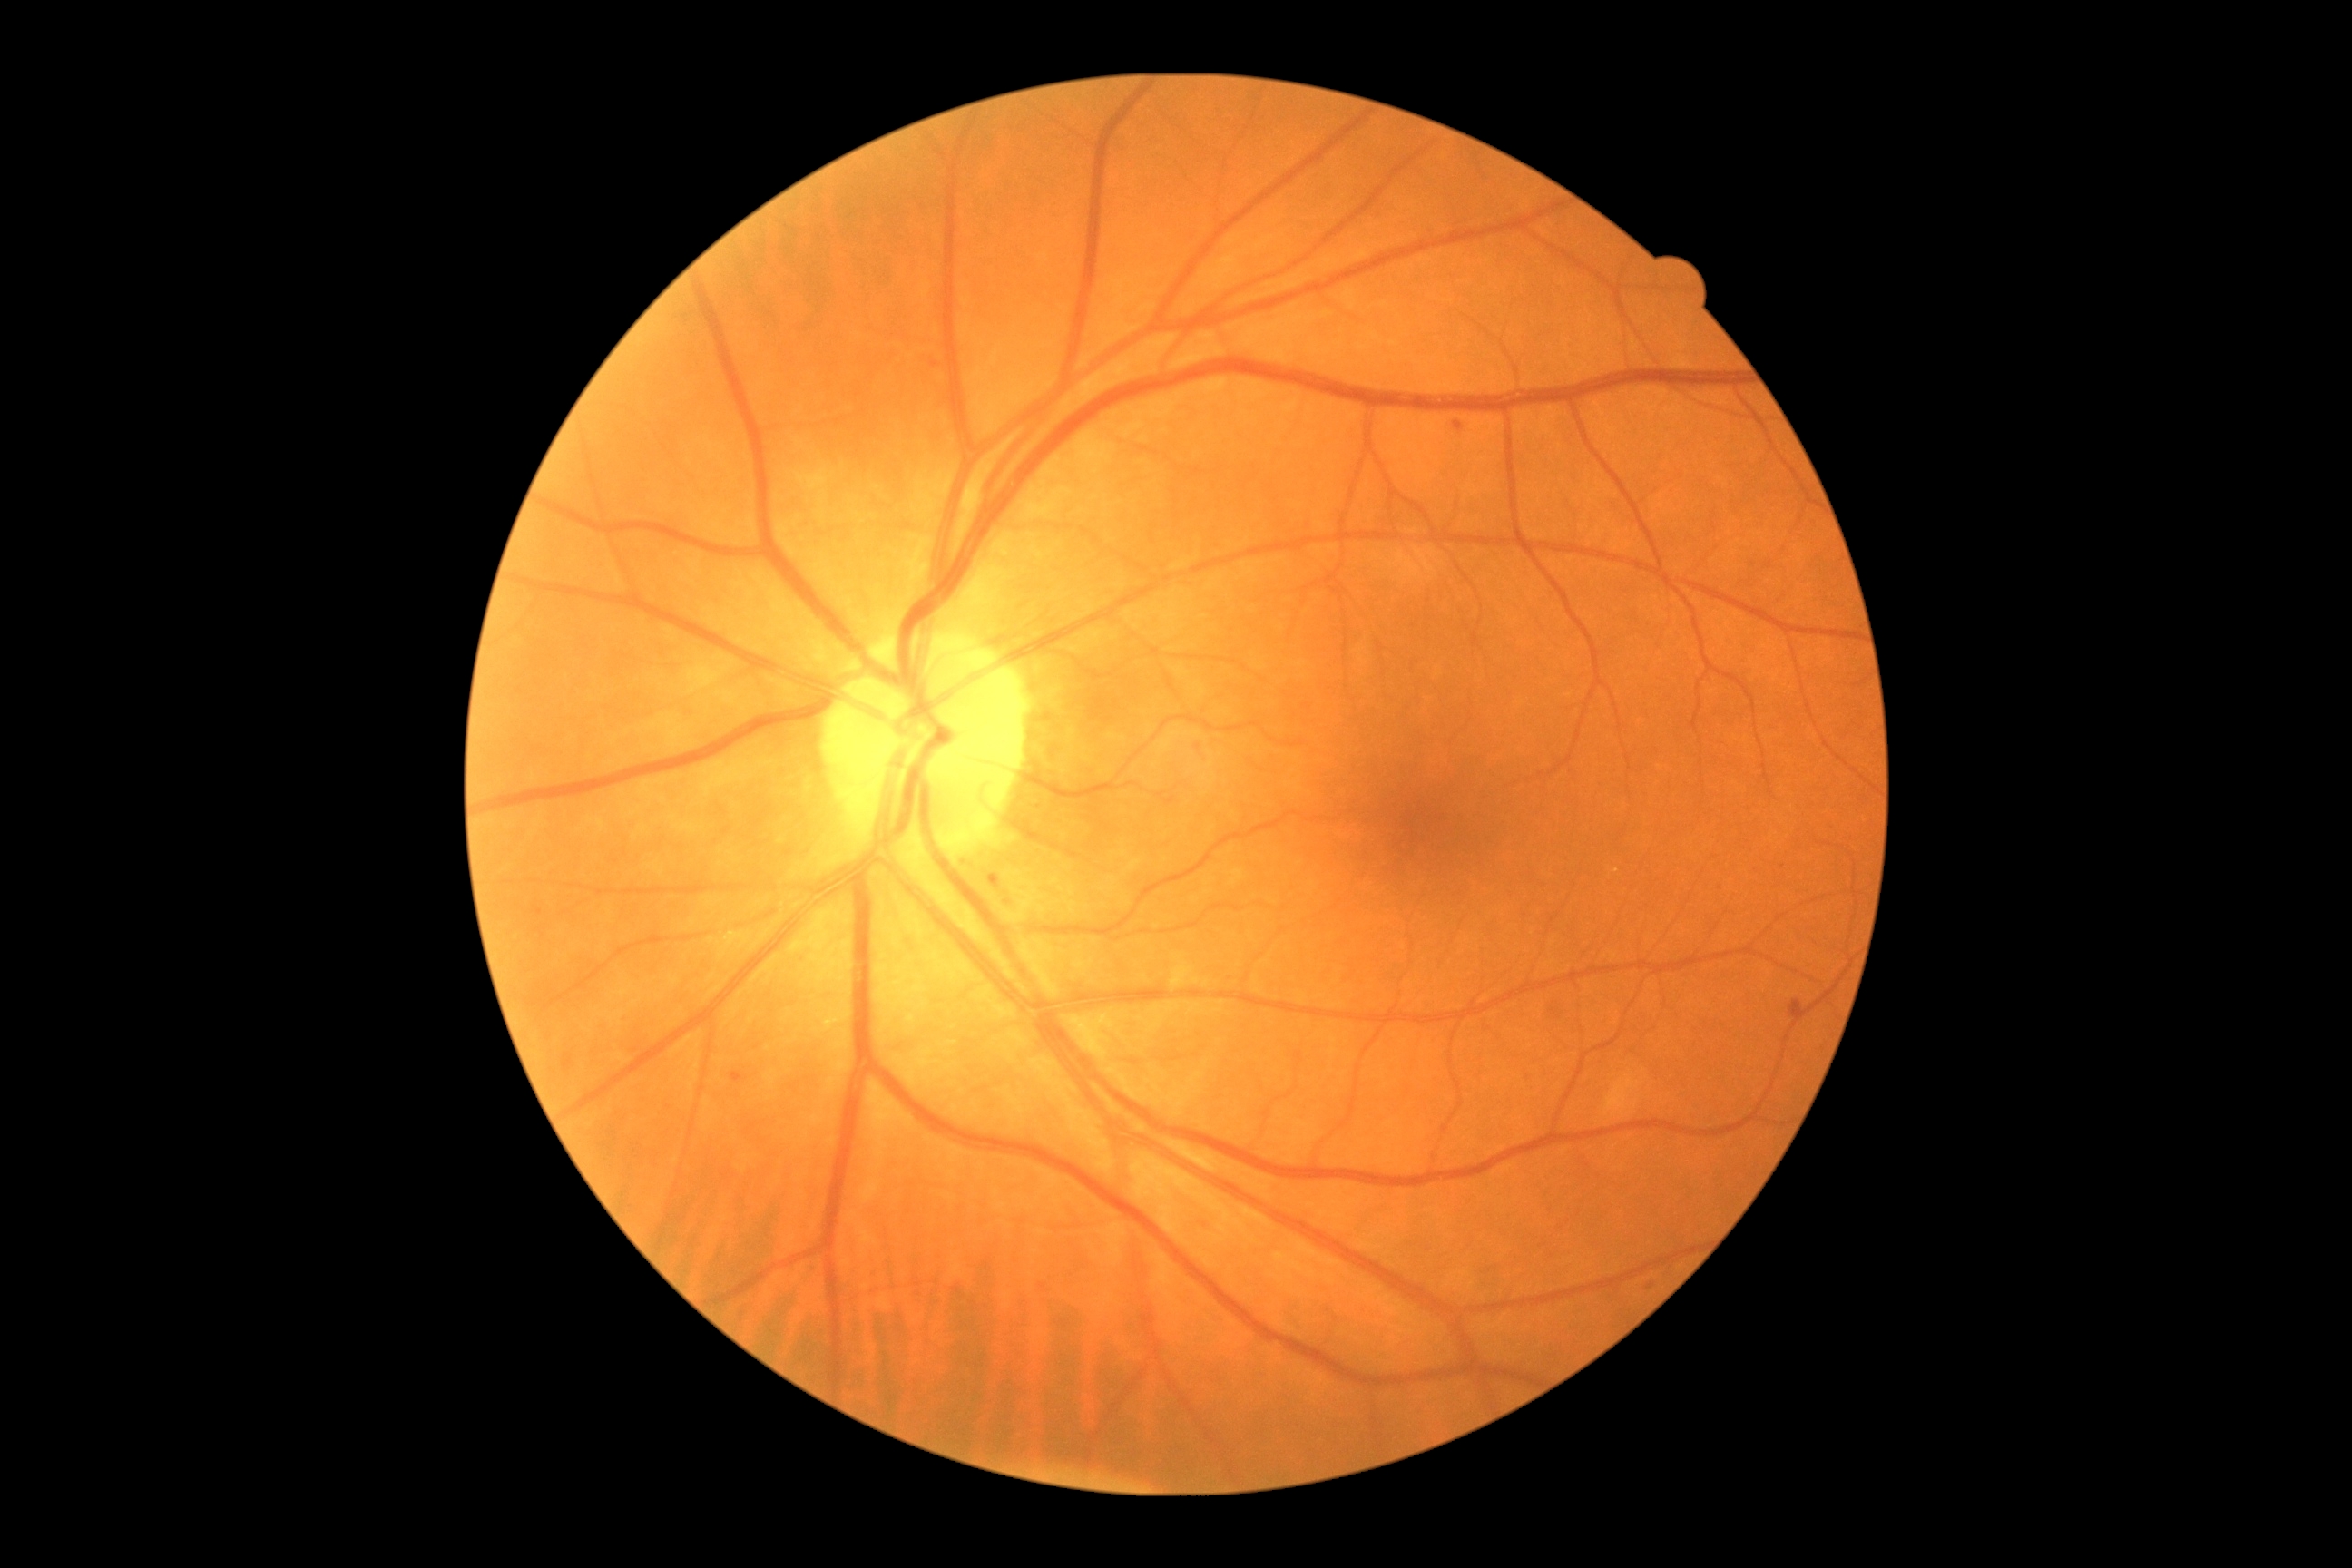
Diabetic retinopathy is grade 1 (mild NPDR)
microaneurysms: [left=930, top=362, right=939, bottom=368] | [left=727, top=1073, right=741, bottom=1081] | [left=1455, top=422, right=1462, bottom=431] | [left=1787, top=1001, right=1801, bottom=1012] | [left=988, top=876, right=999, bottom=885]
Small microaneurysms approximately at [1650, 1286] | [1783, 866]
hemorrhages: none
hard exudates: none
soft exudates: none